45° FOV; color fundus photograph — 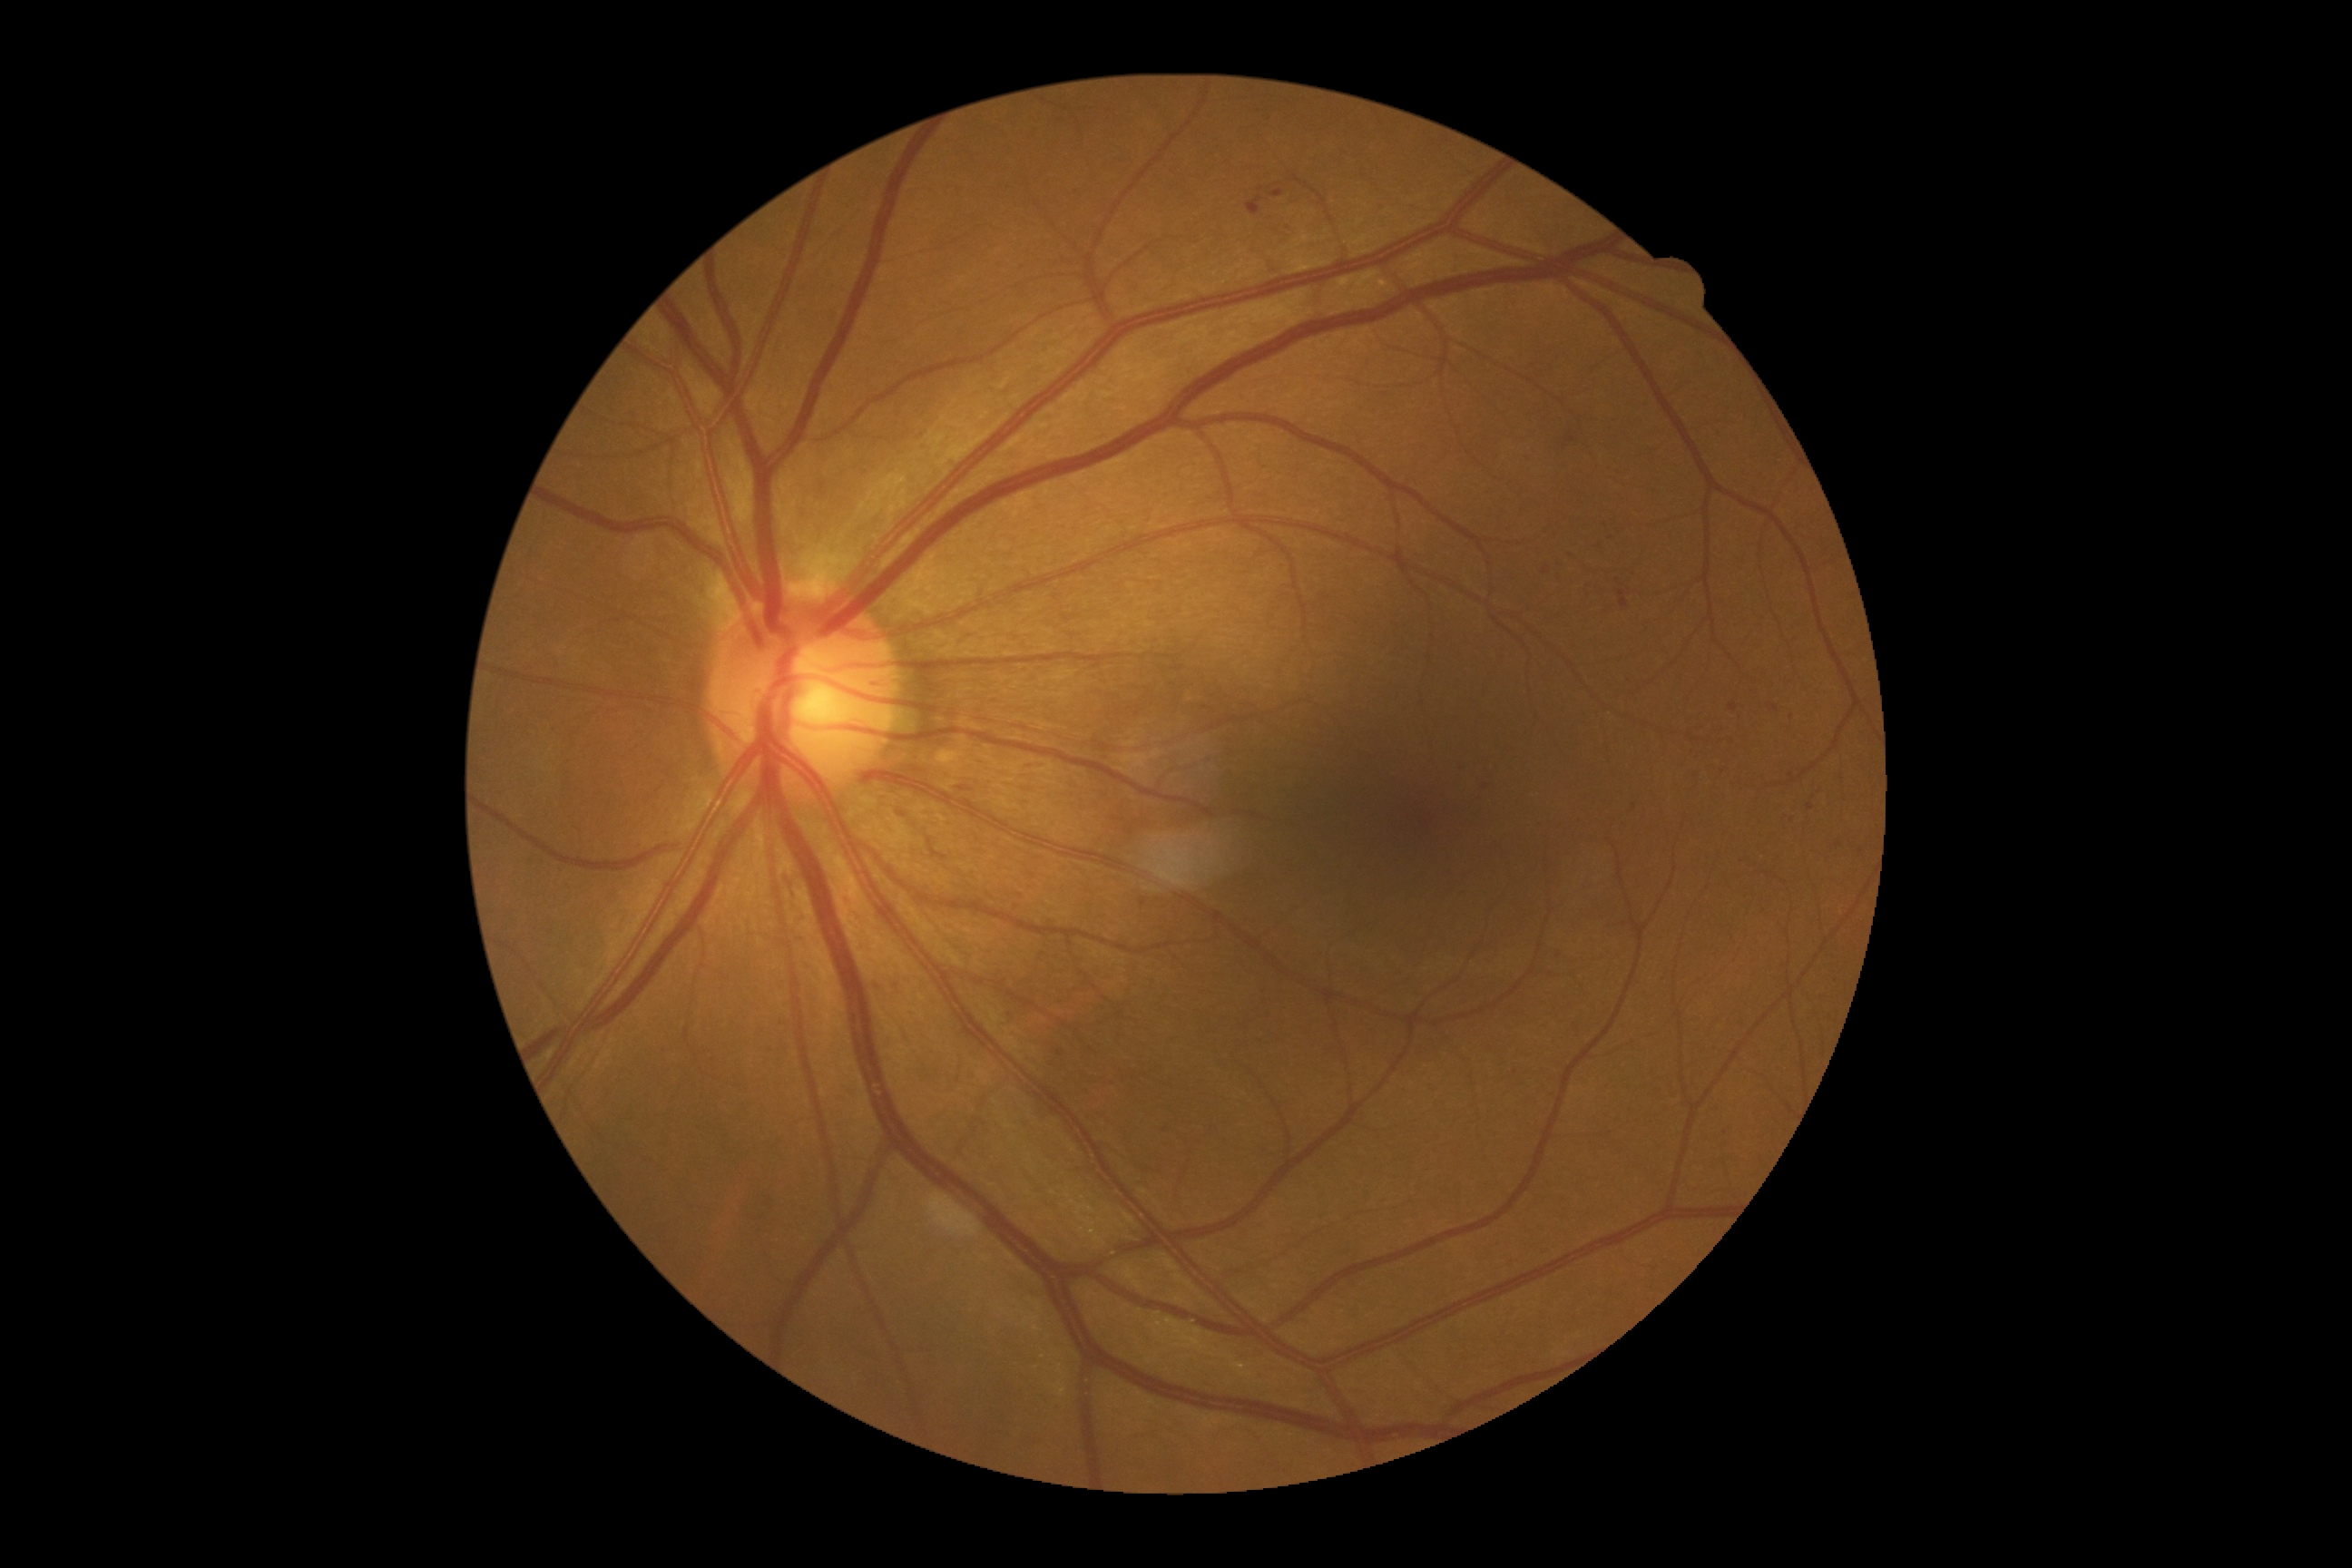
Diabetic retinopathy grade: 2.